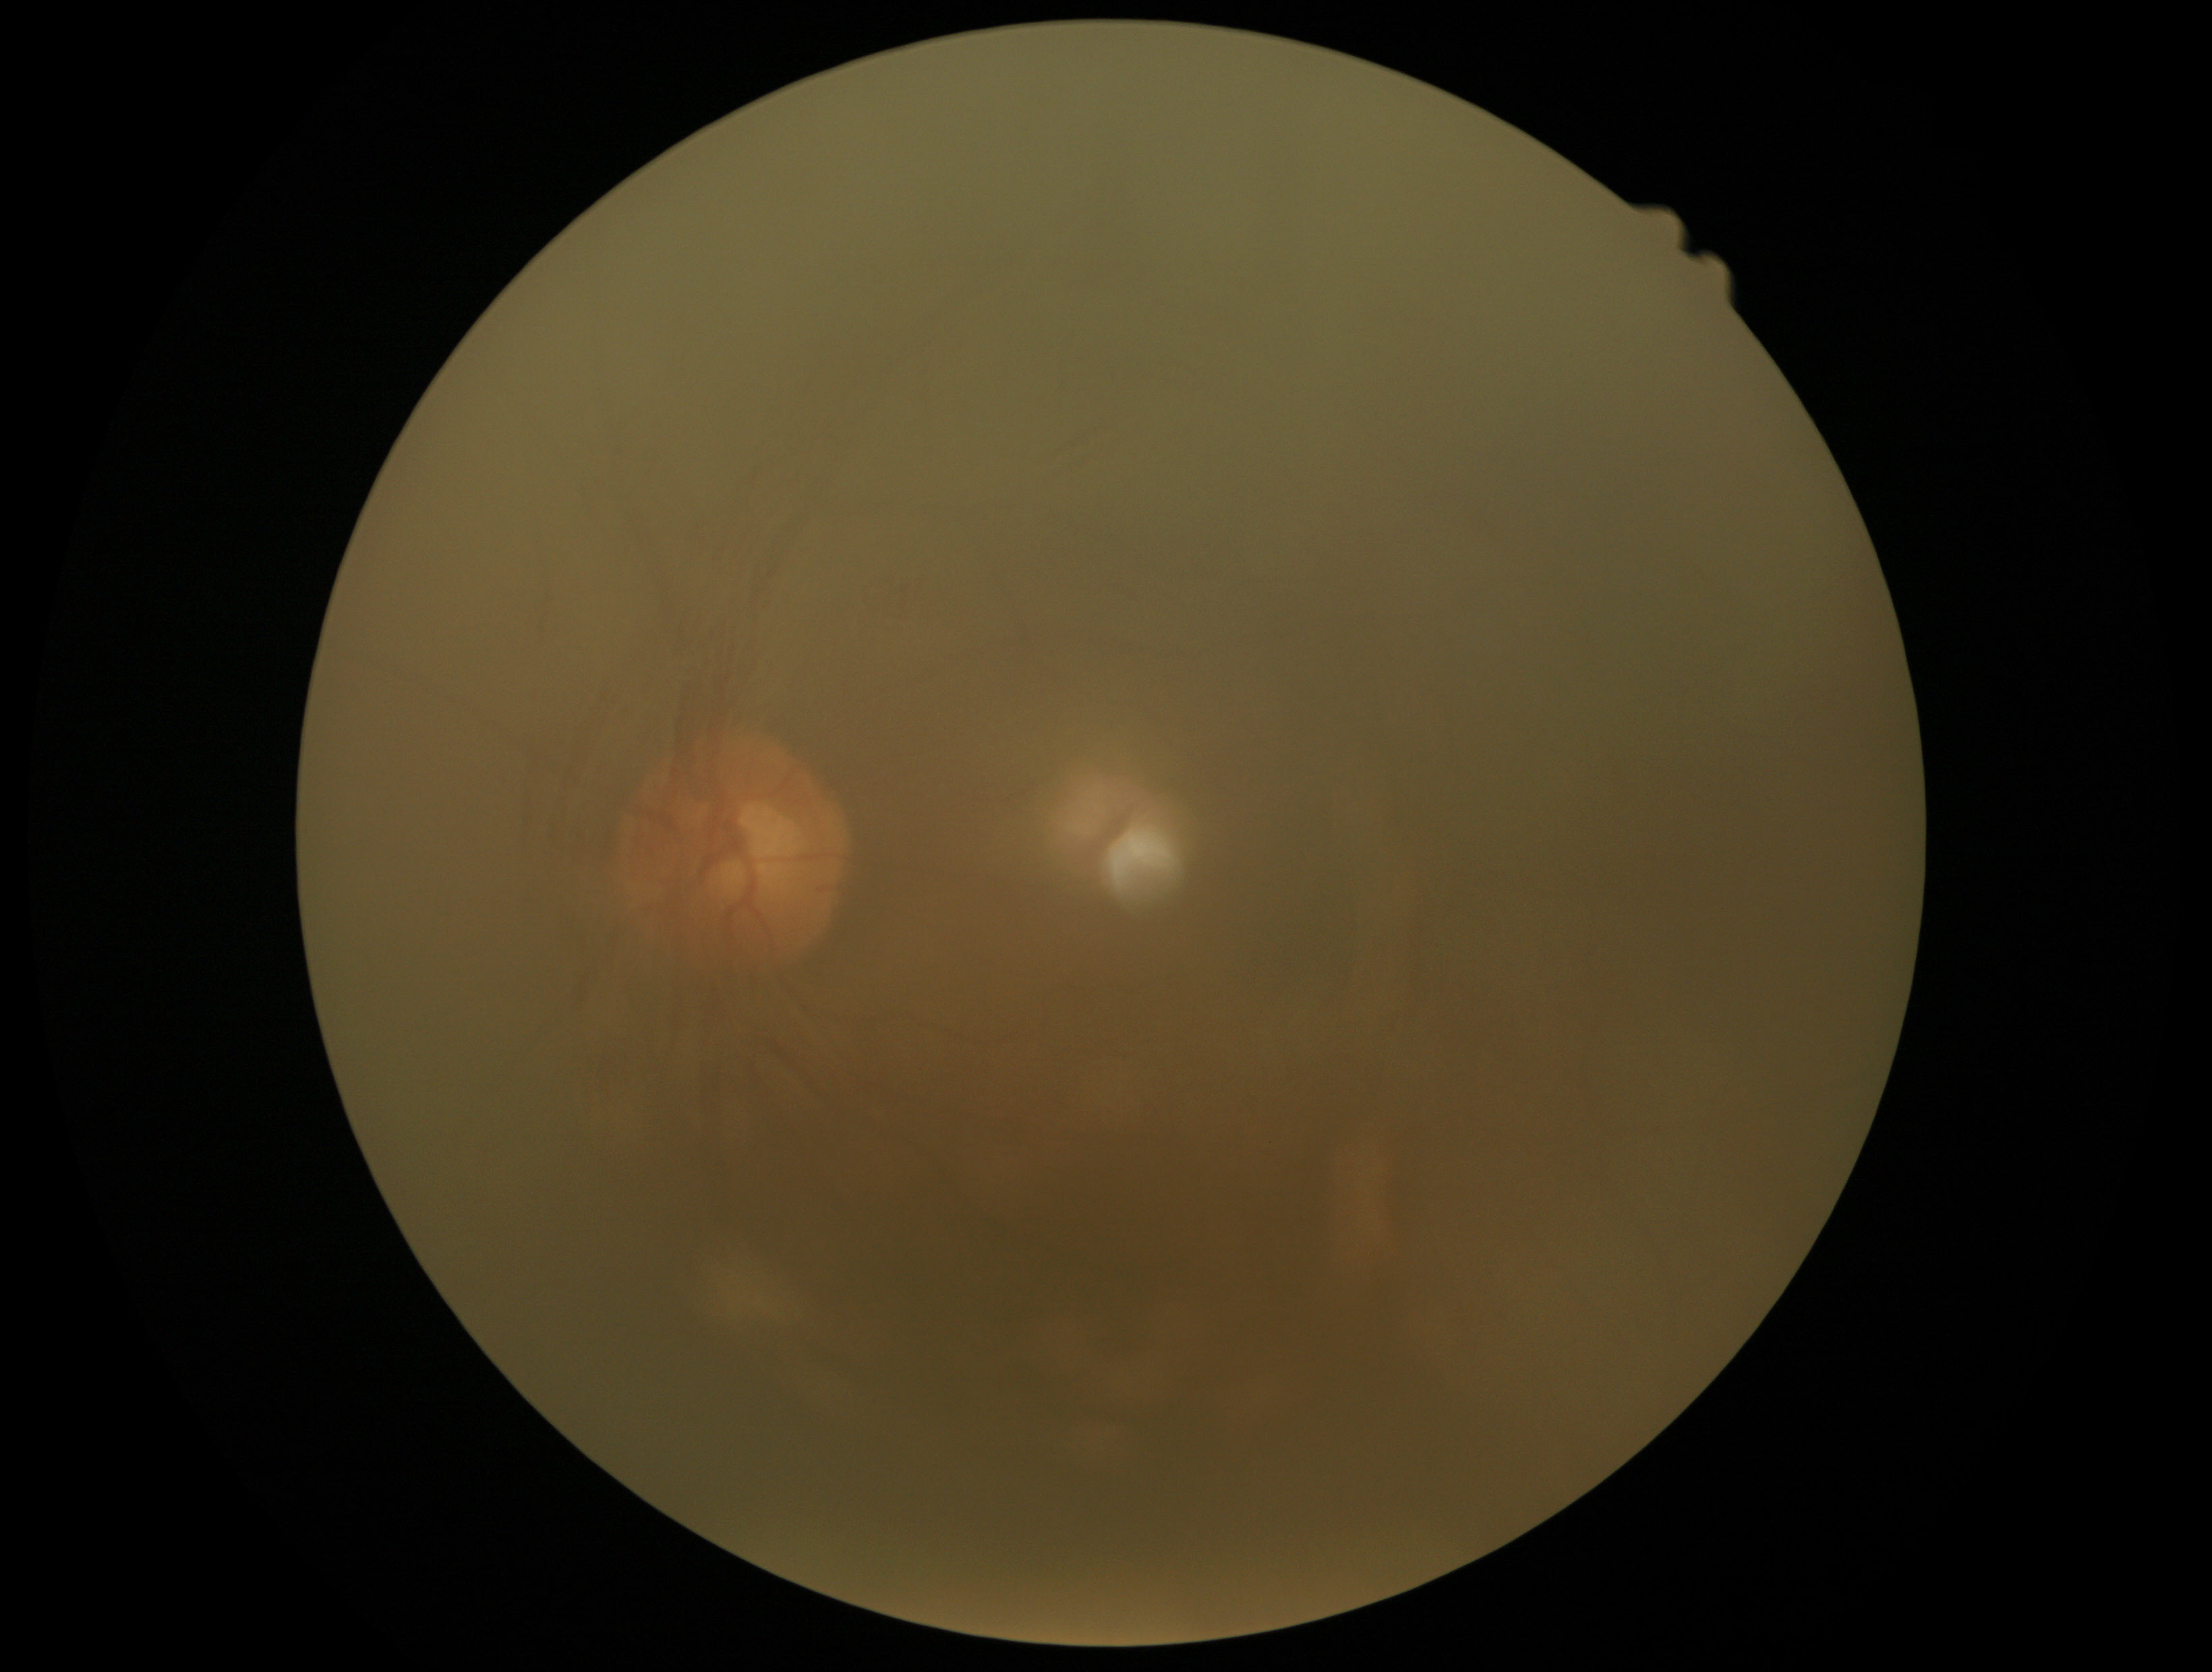 dr_grade: ungradable